Dilated-pupil acquisition; captured on a Topcon TRC-NW8 fundus camera; image size 1932x1932
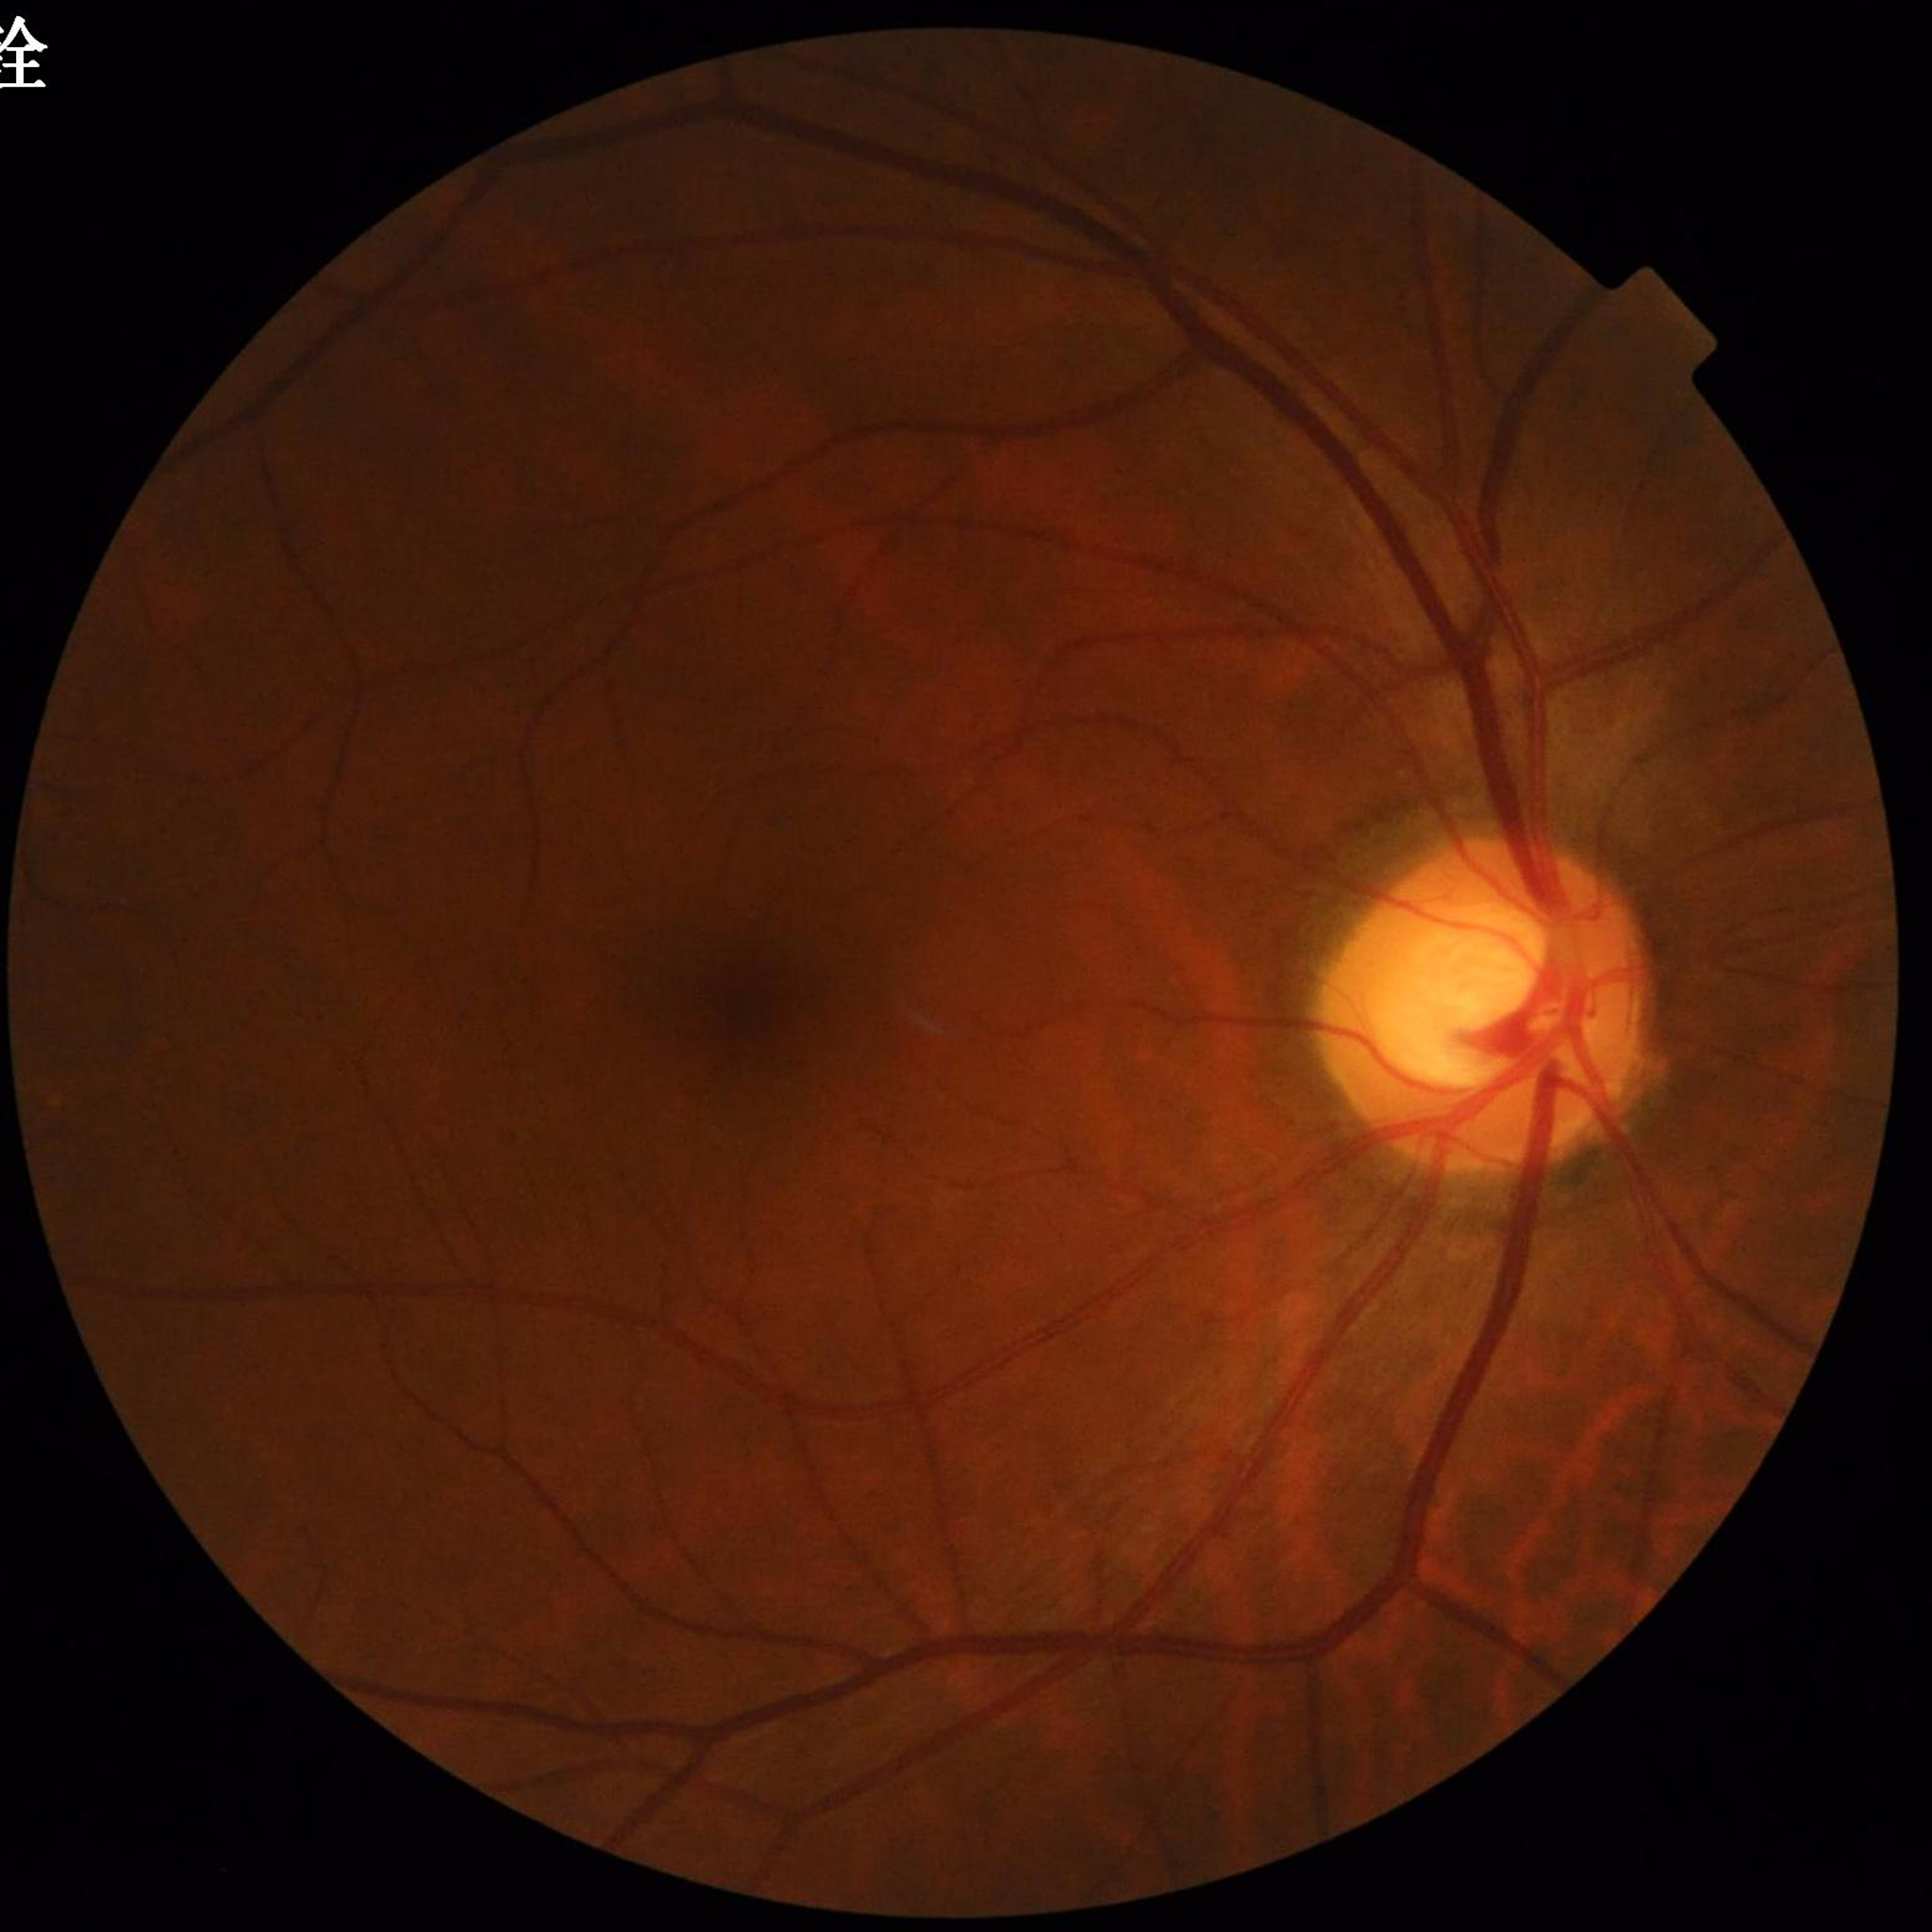 Patient diagnosed with glaucoma.
Photo quality: satisfactory.